Cropped to the optic nerve head
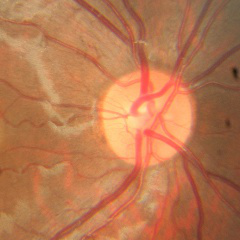 There is evidence of no glaucomatous findings.